Retinal fundus photograph · 512 x 512 pixels — 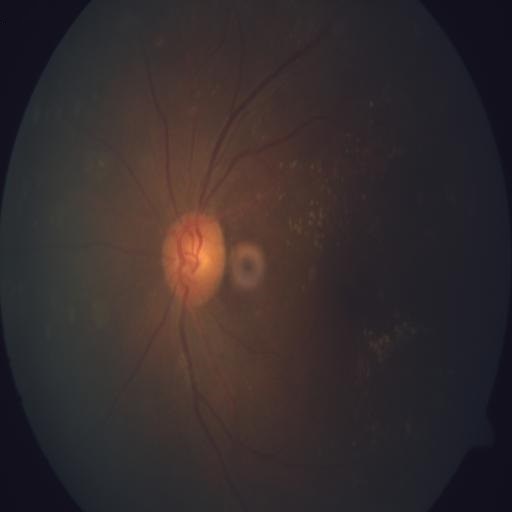
Findings consistent with DN (drusen).